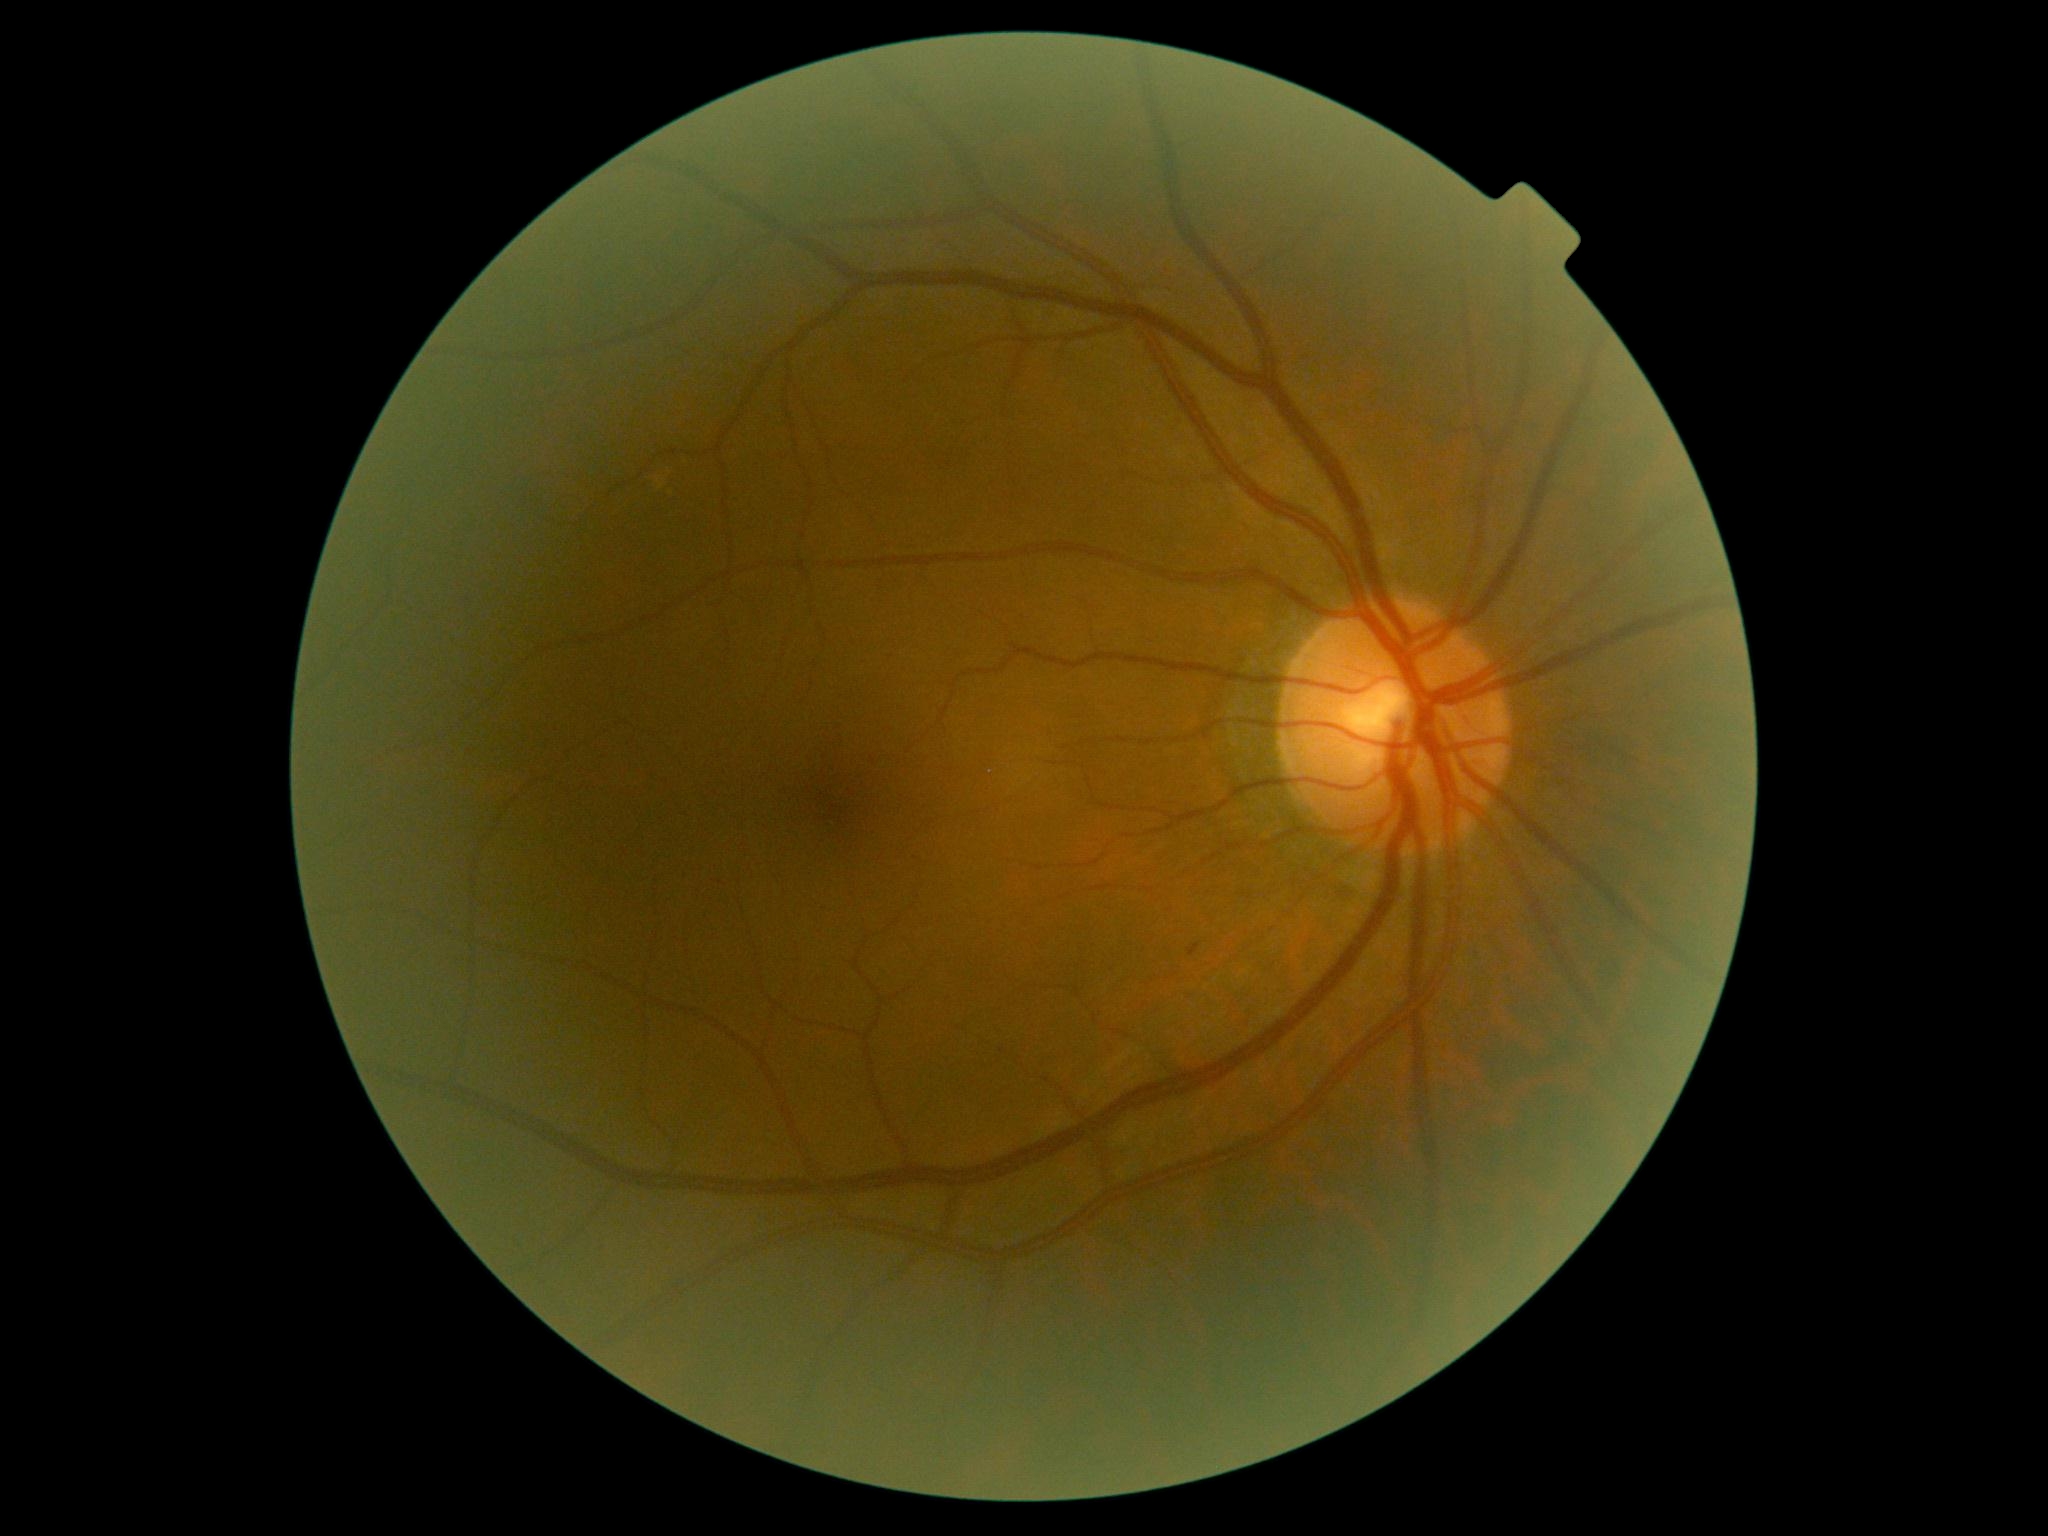

dr_grade: grade 1